1240x1240px · Phoenix ICON wide-field infant fundus image — 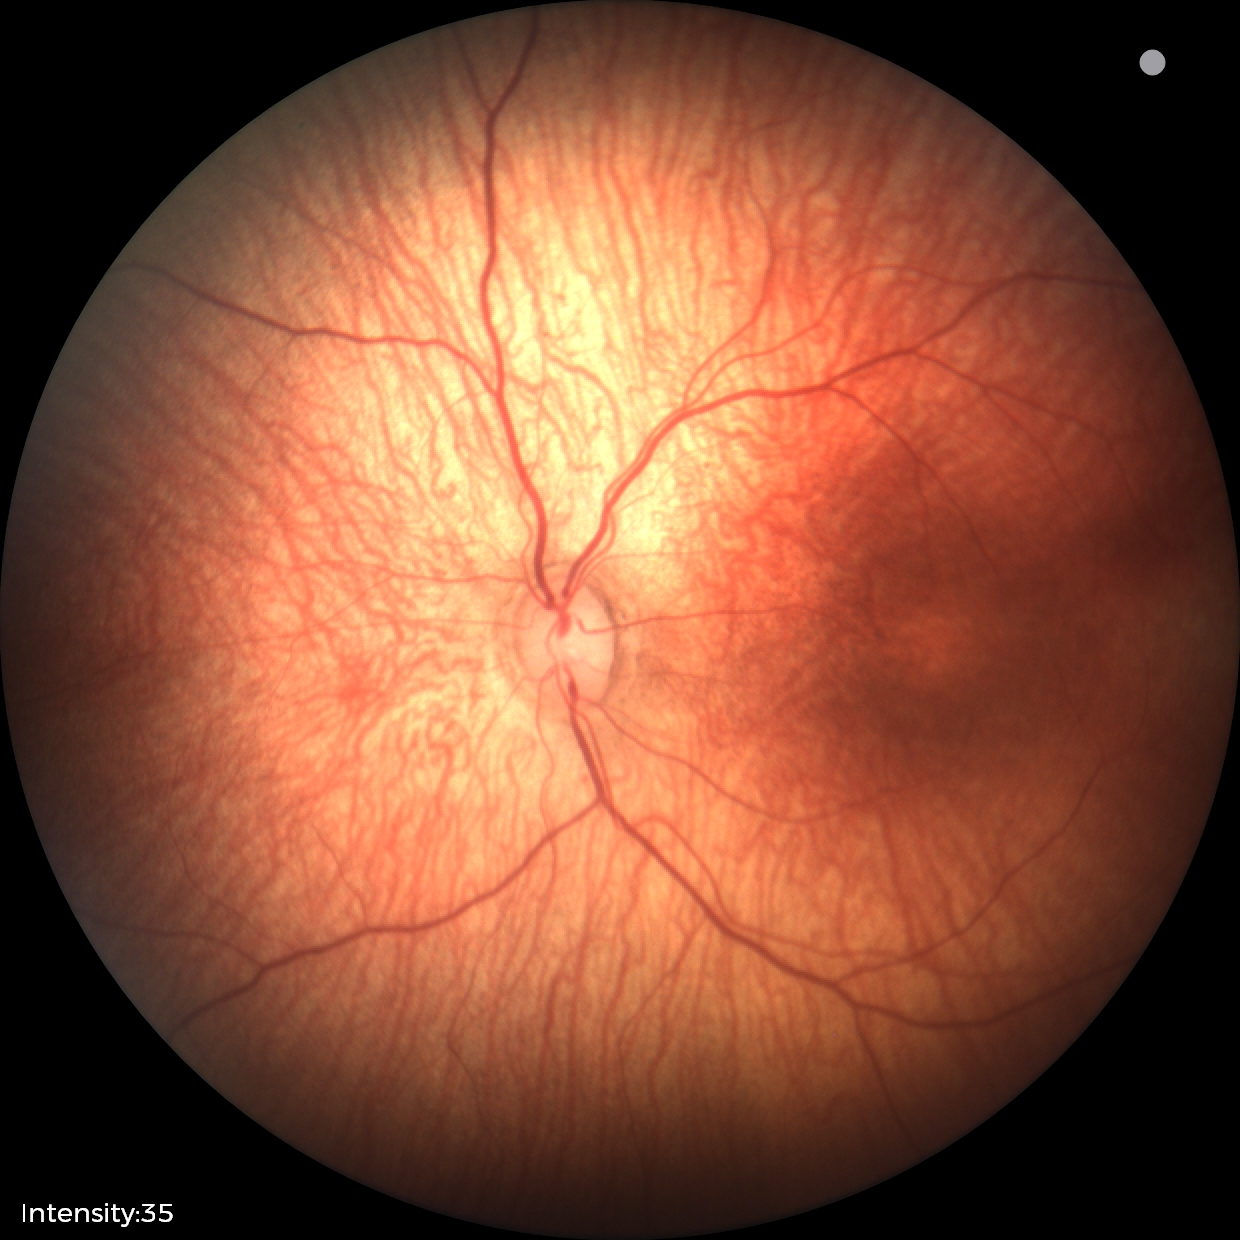

From an examination with diagnosis of status post retinopathy of prematurity.